45-degree field of view. 2352 x 1568 pixels — 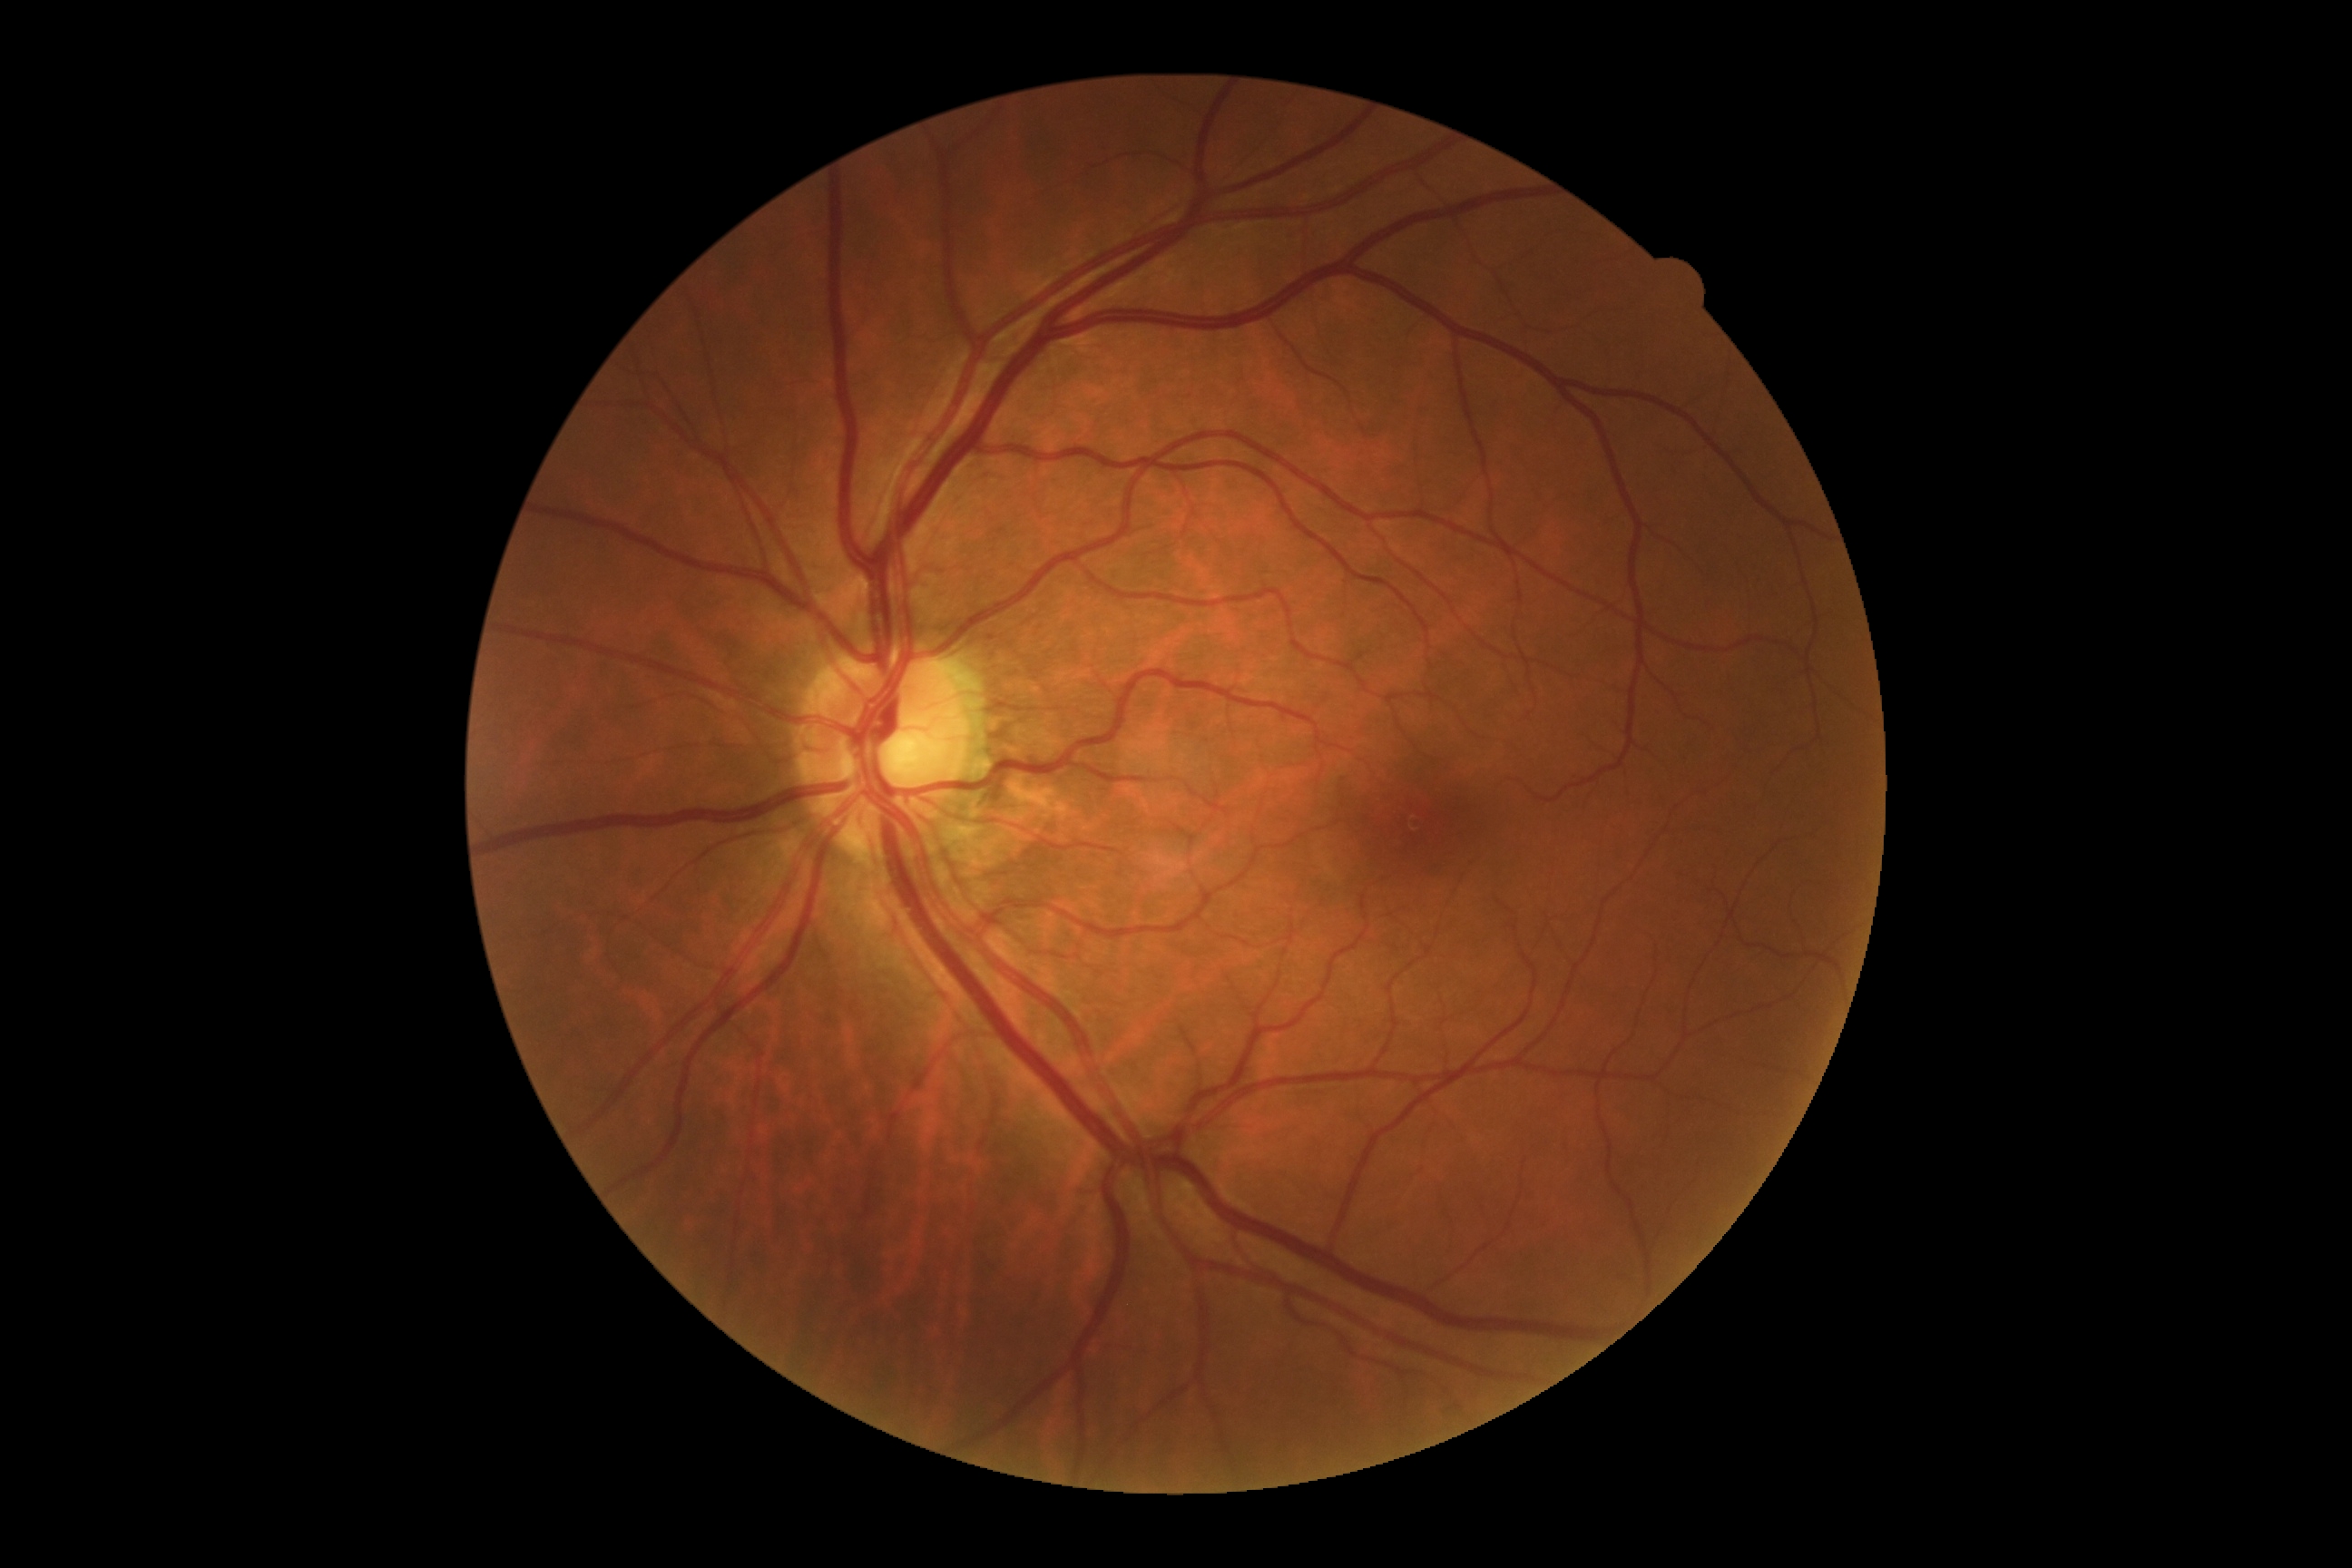
No signs of diabetic retinopathy.
DR grade is 0.